DR severity per modified Davis staging
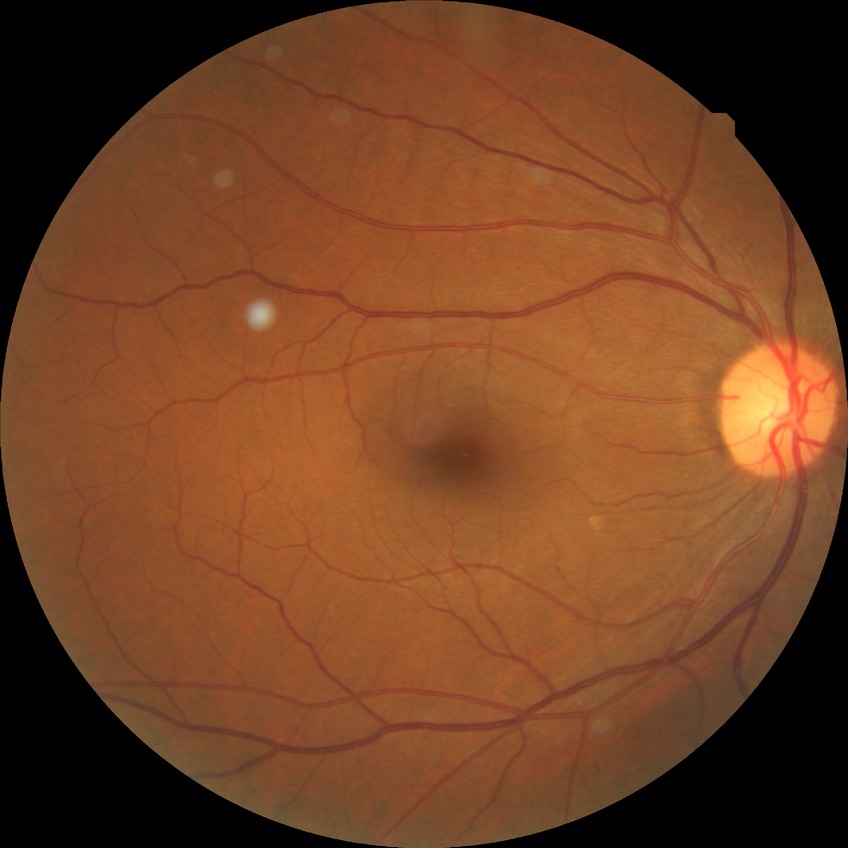 Diabetic retinopathy (DR): NDR (no diabetic retinopathy).